2184x1690:
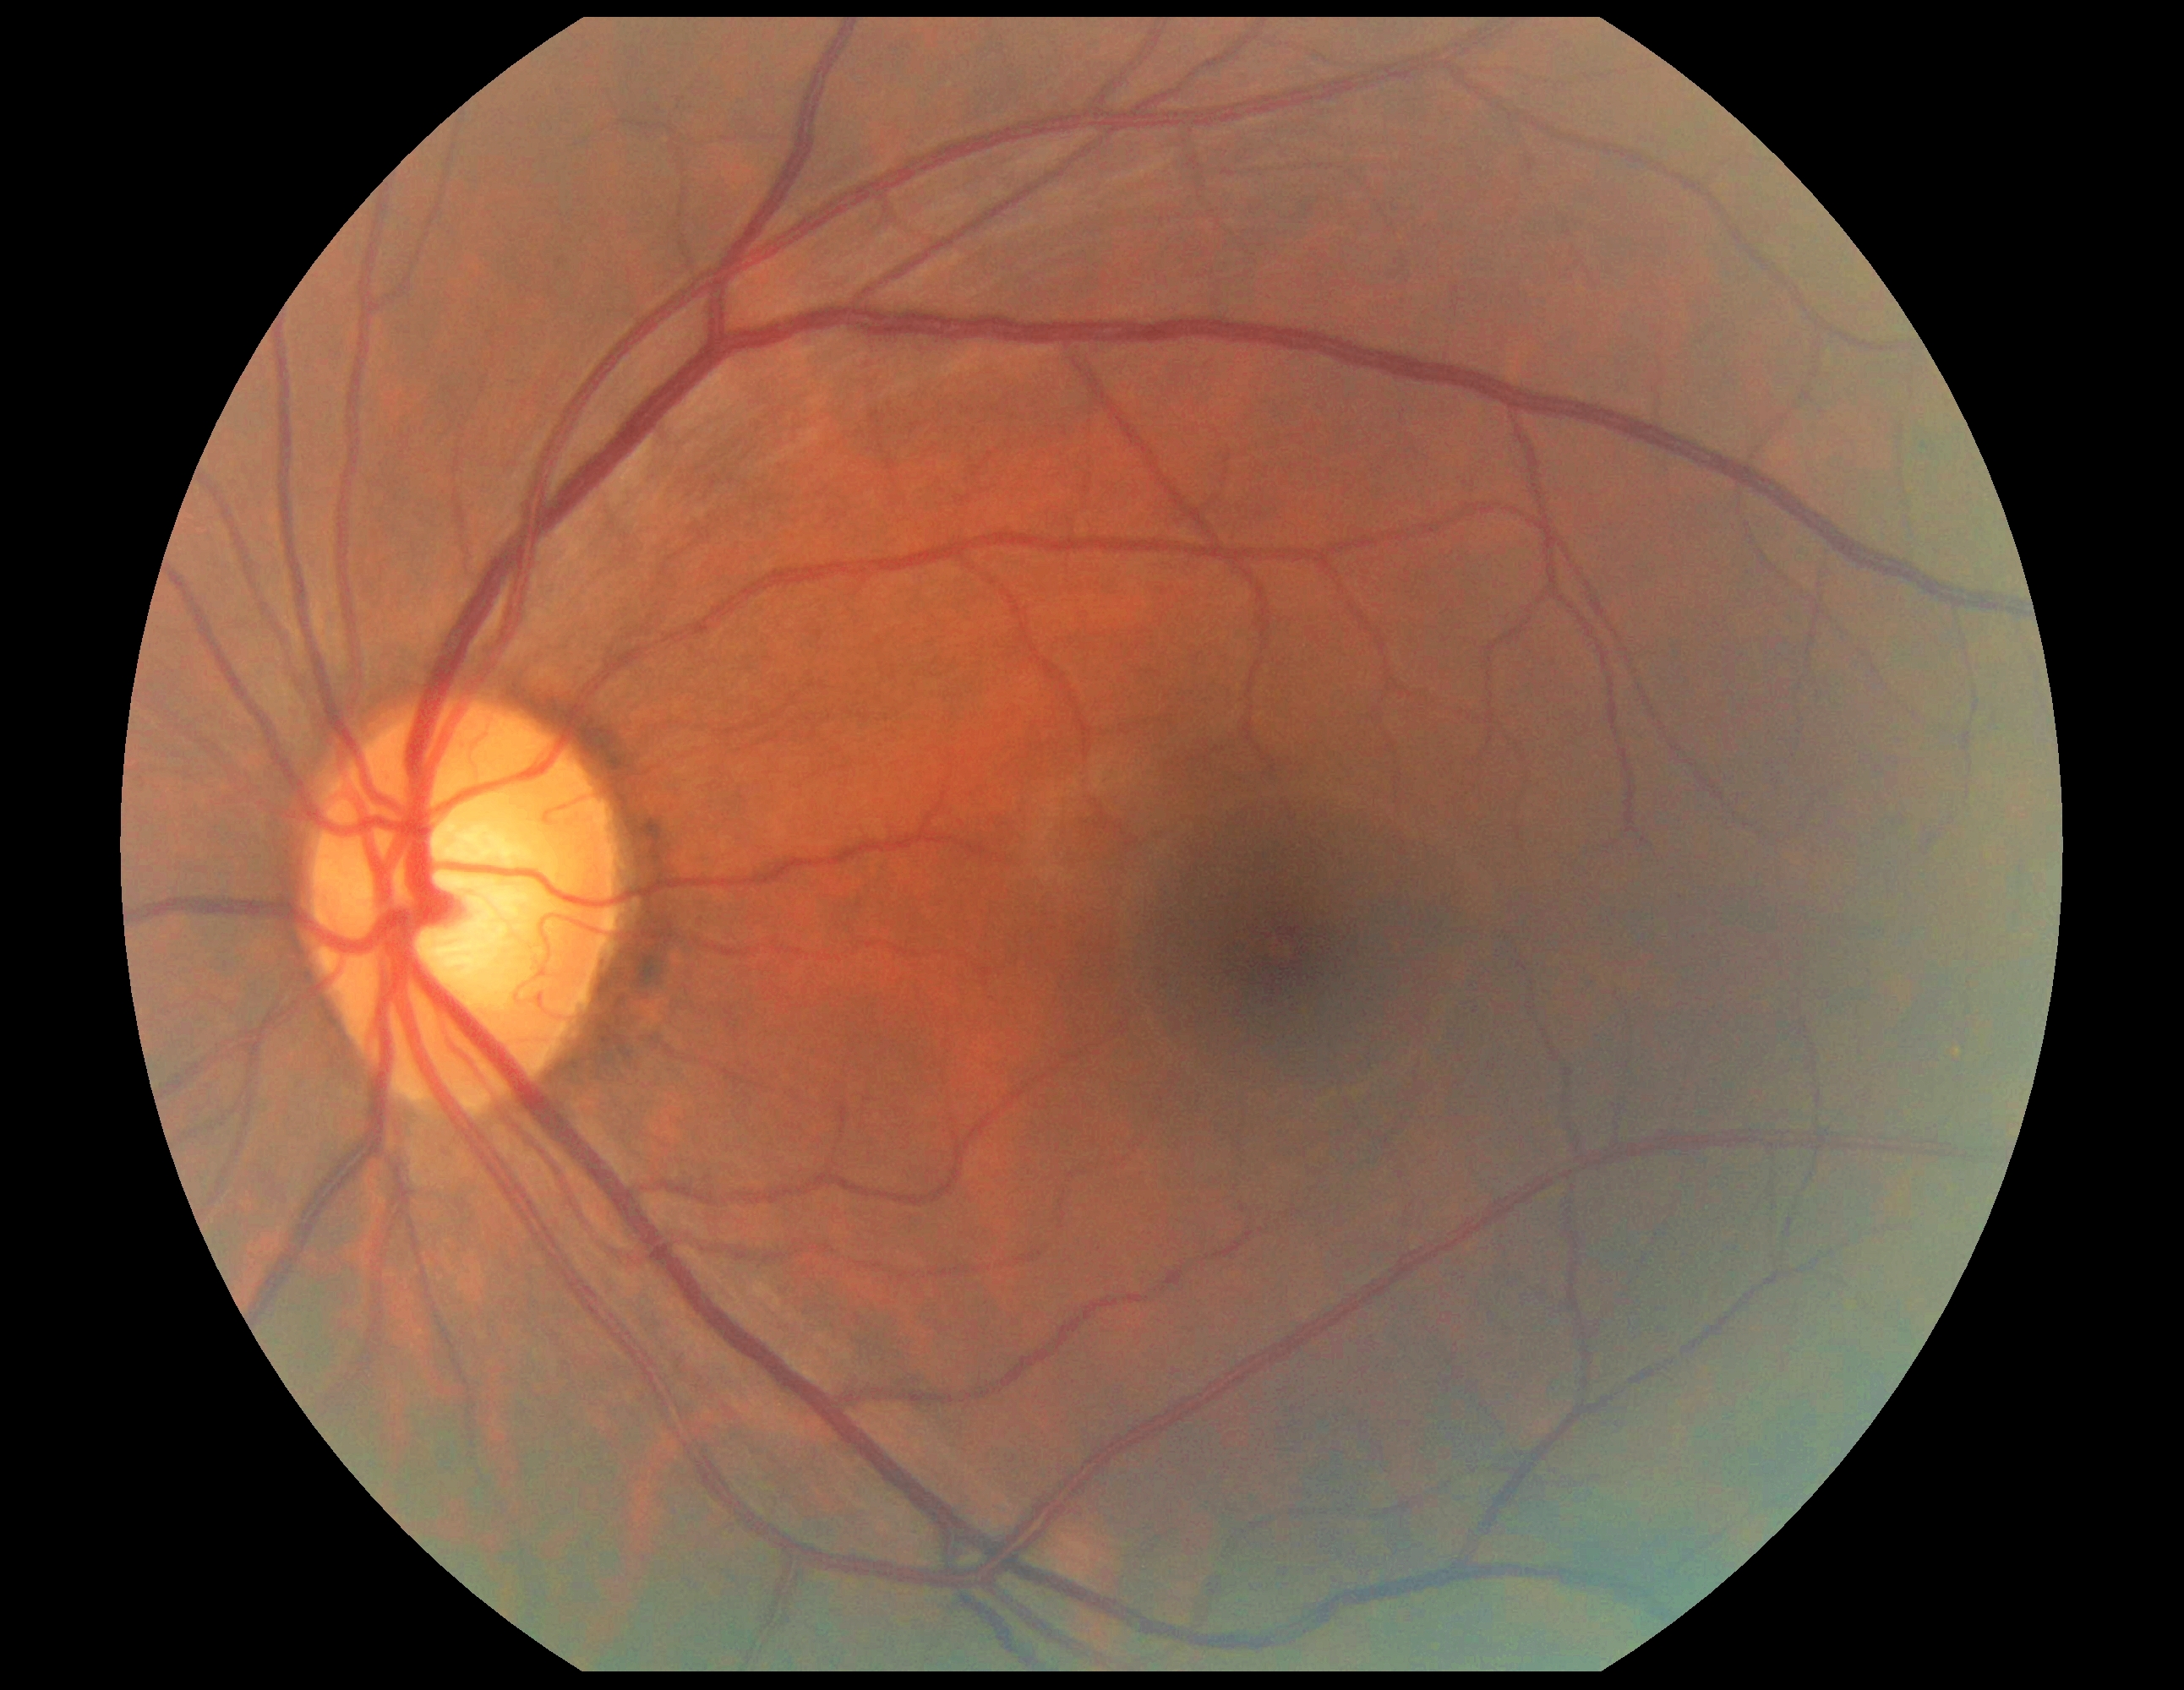

{"dr_grade": "grade 0 (no apparent retinopathy)"}